FOV: 45 degrees
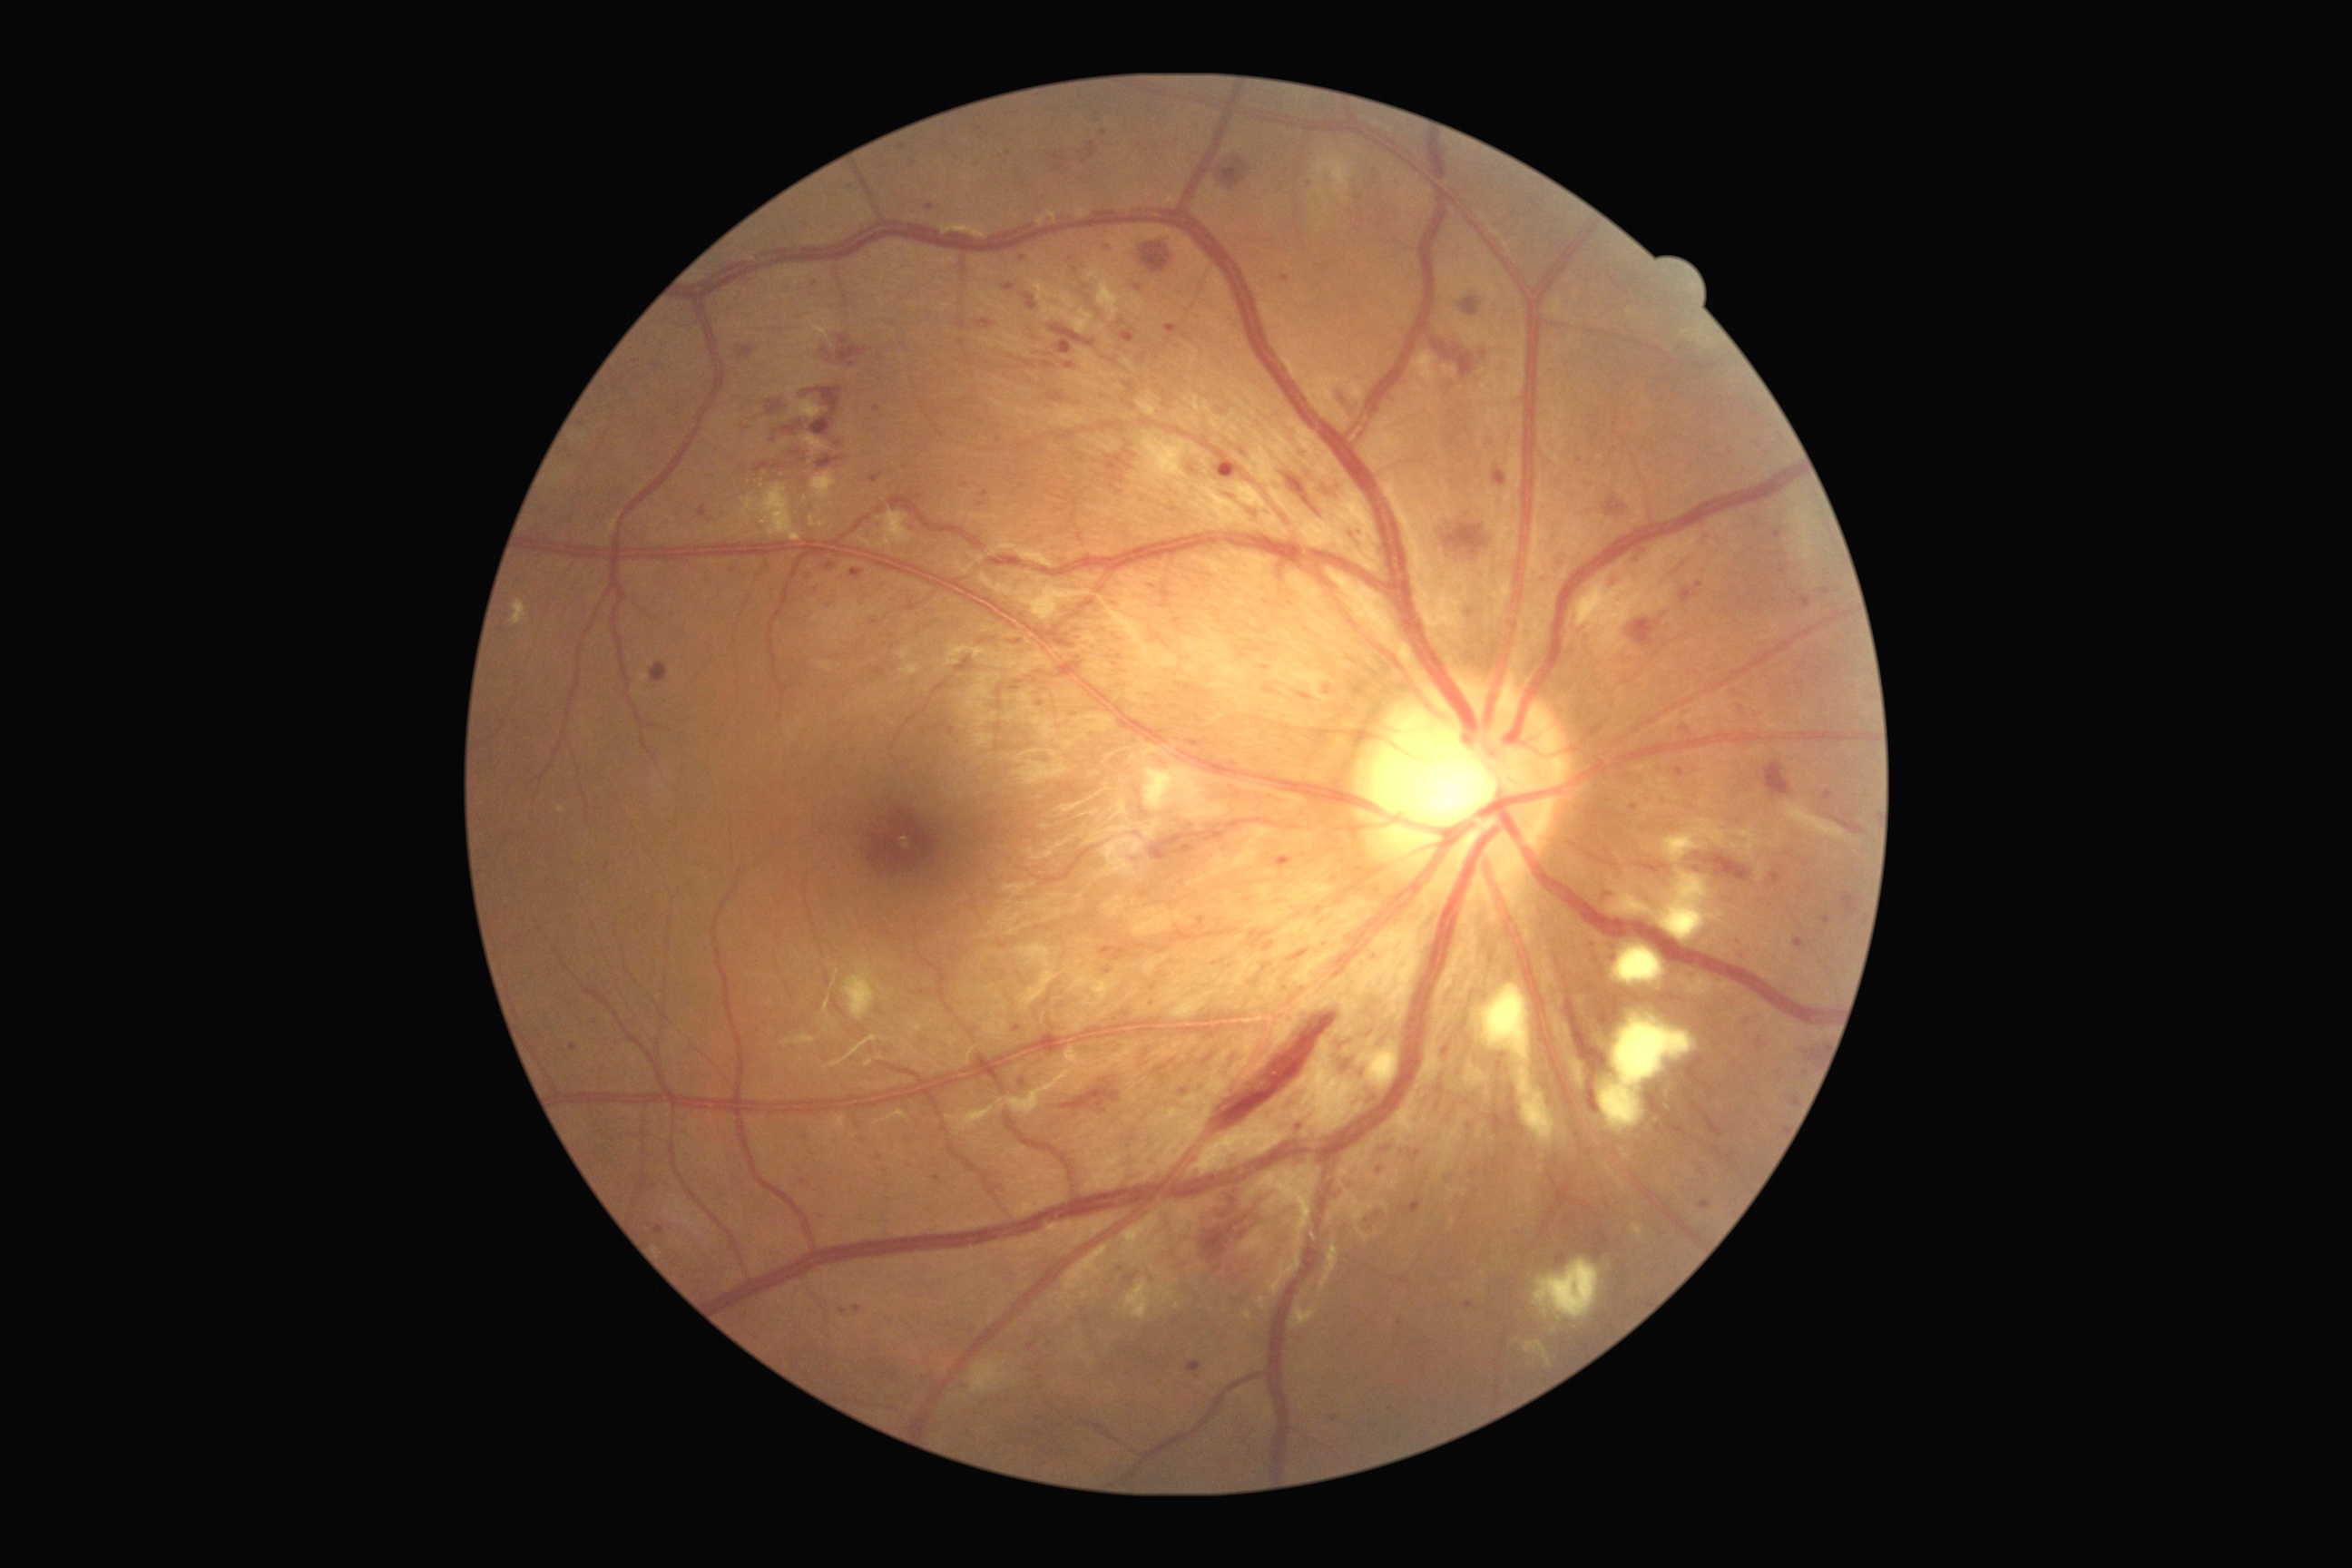
DR = severe NPDR (grade 3).